45° FOV; color fundus photograph: 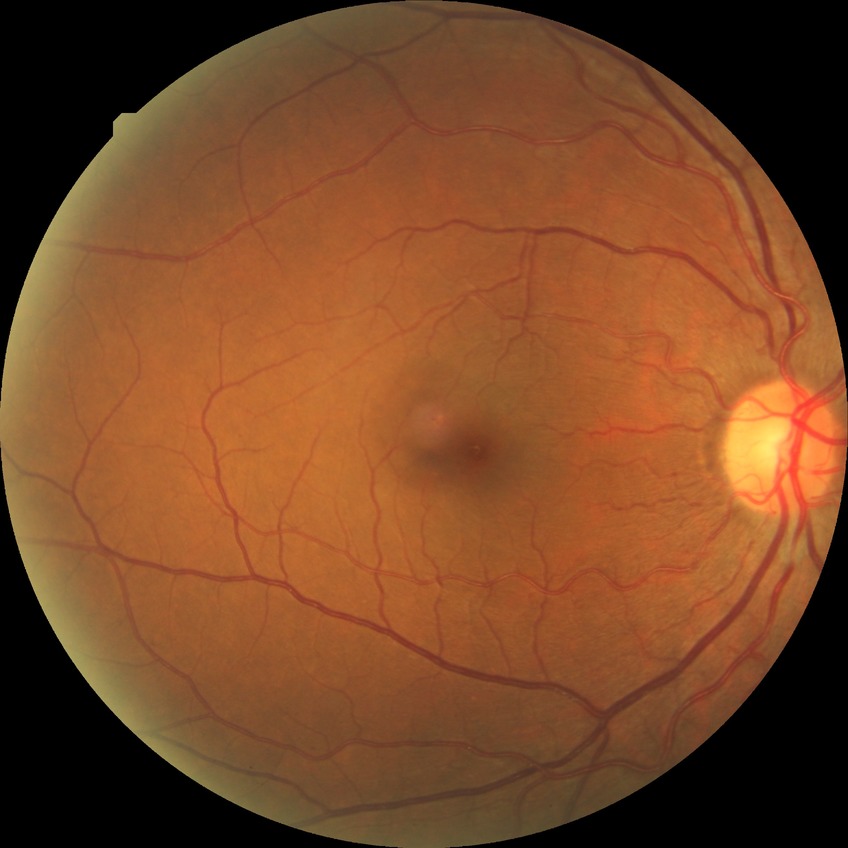

diabetic retinopathy (DR) = simple diabetic retinopathy (SDR)